45° field of view; NIDEK AFC-230; graded on the modified Davis scale: 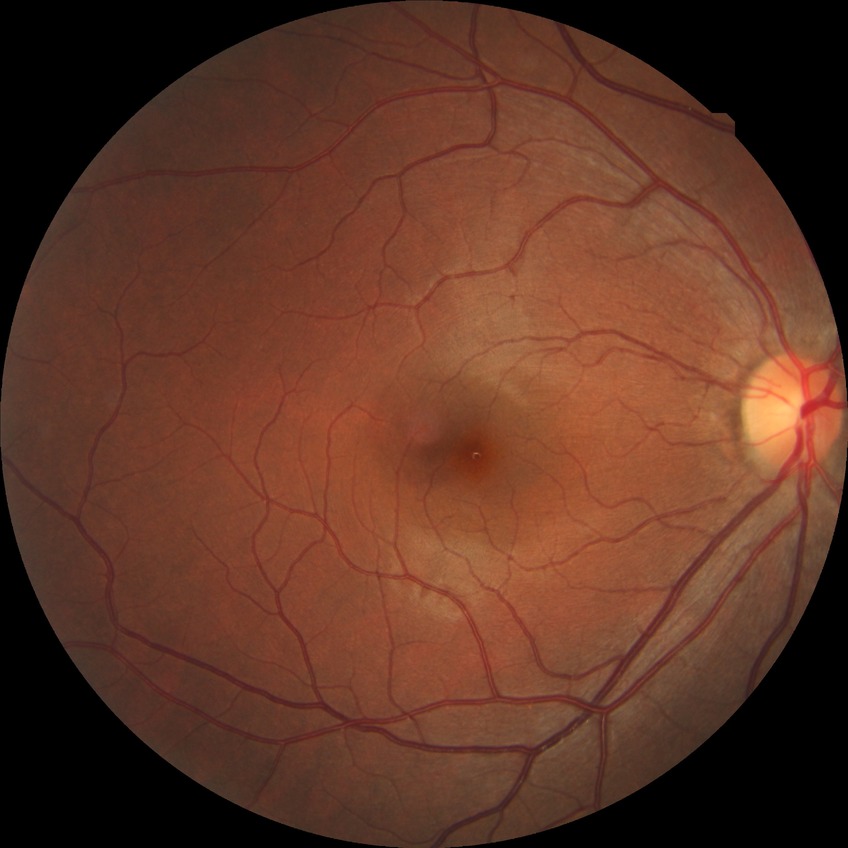 Assessment:
* modified Davis classification — no diabetic retinopathy